Color fundus photograph: 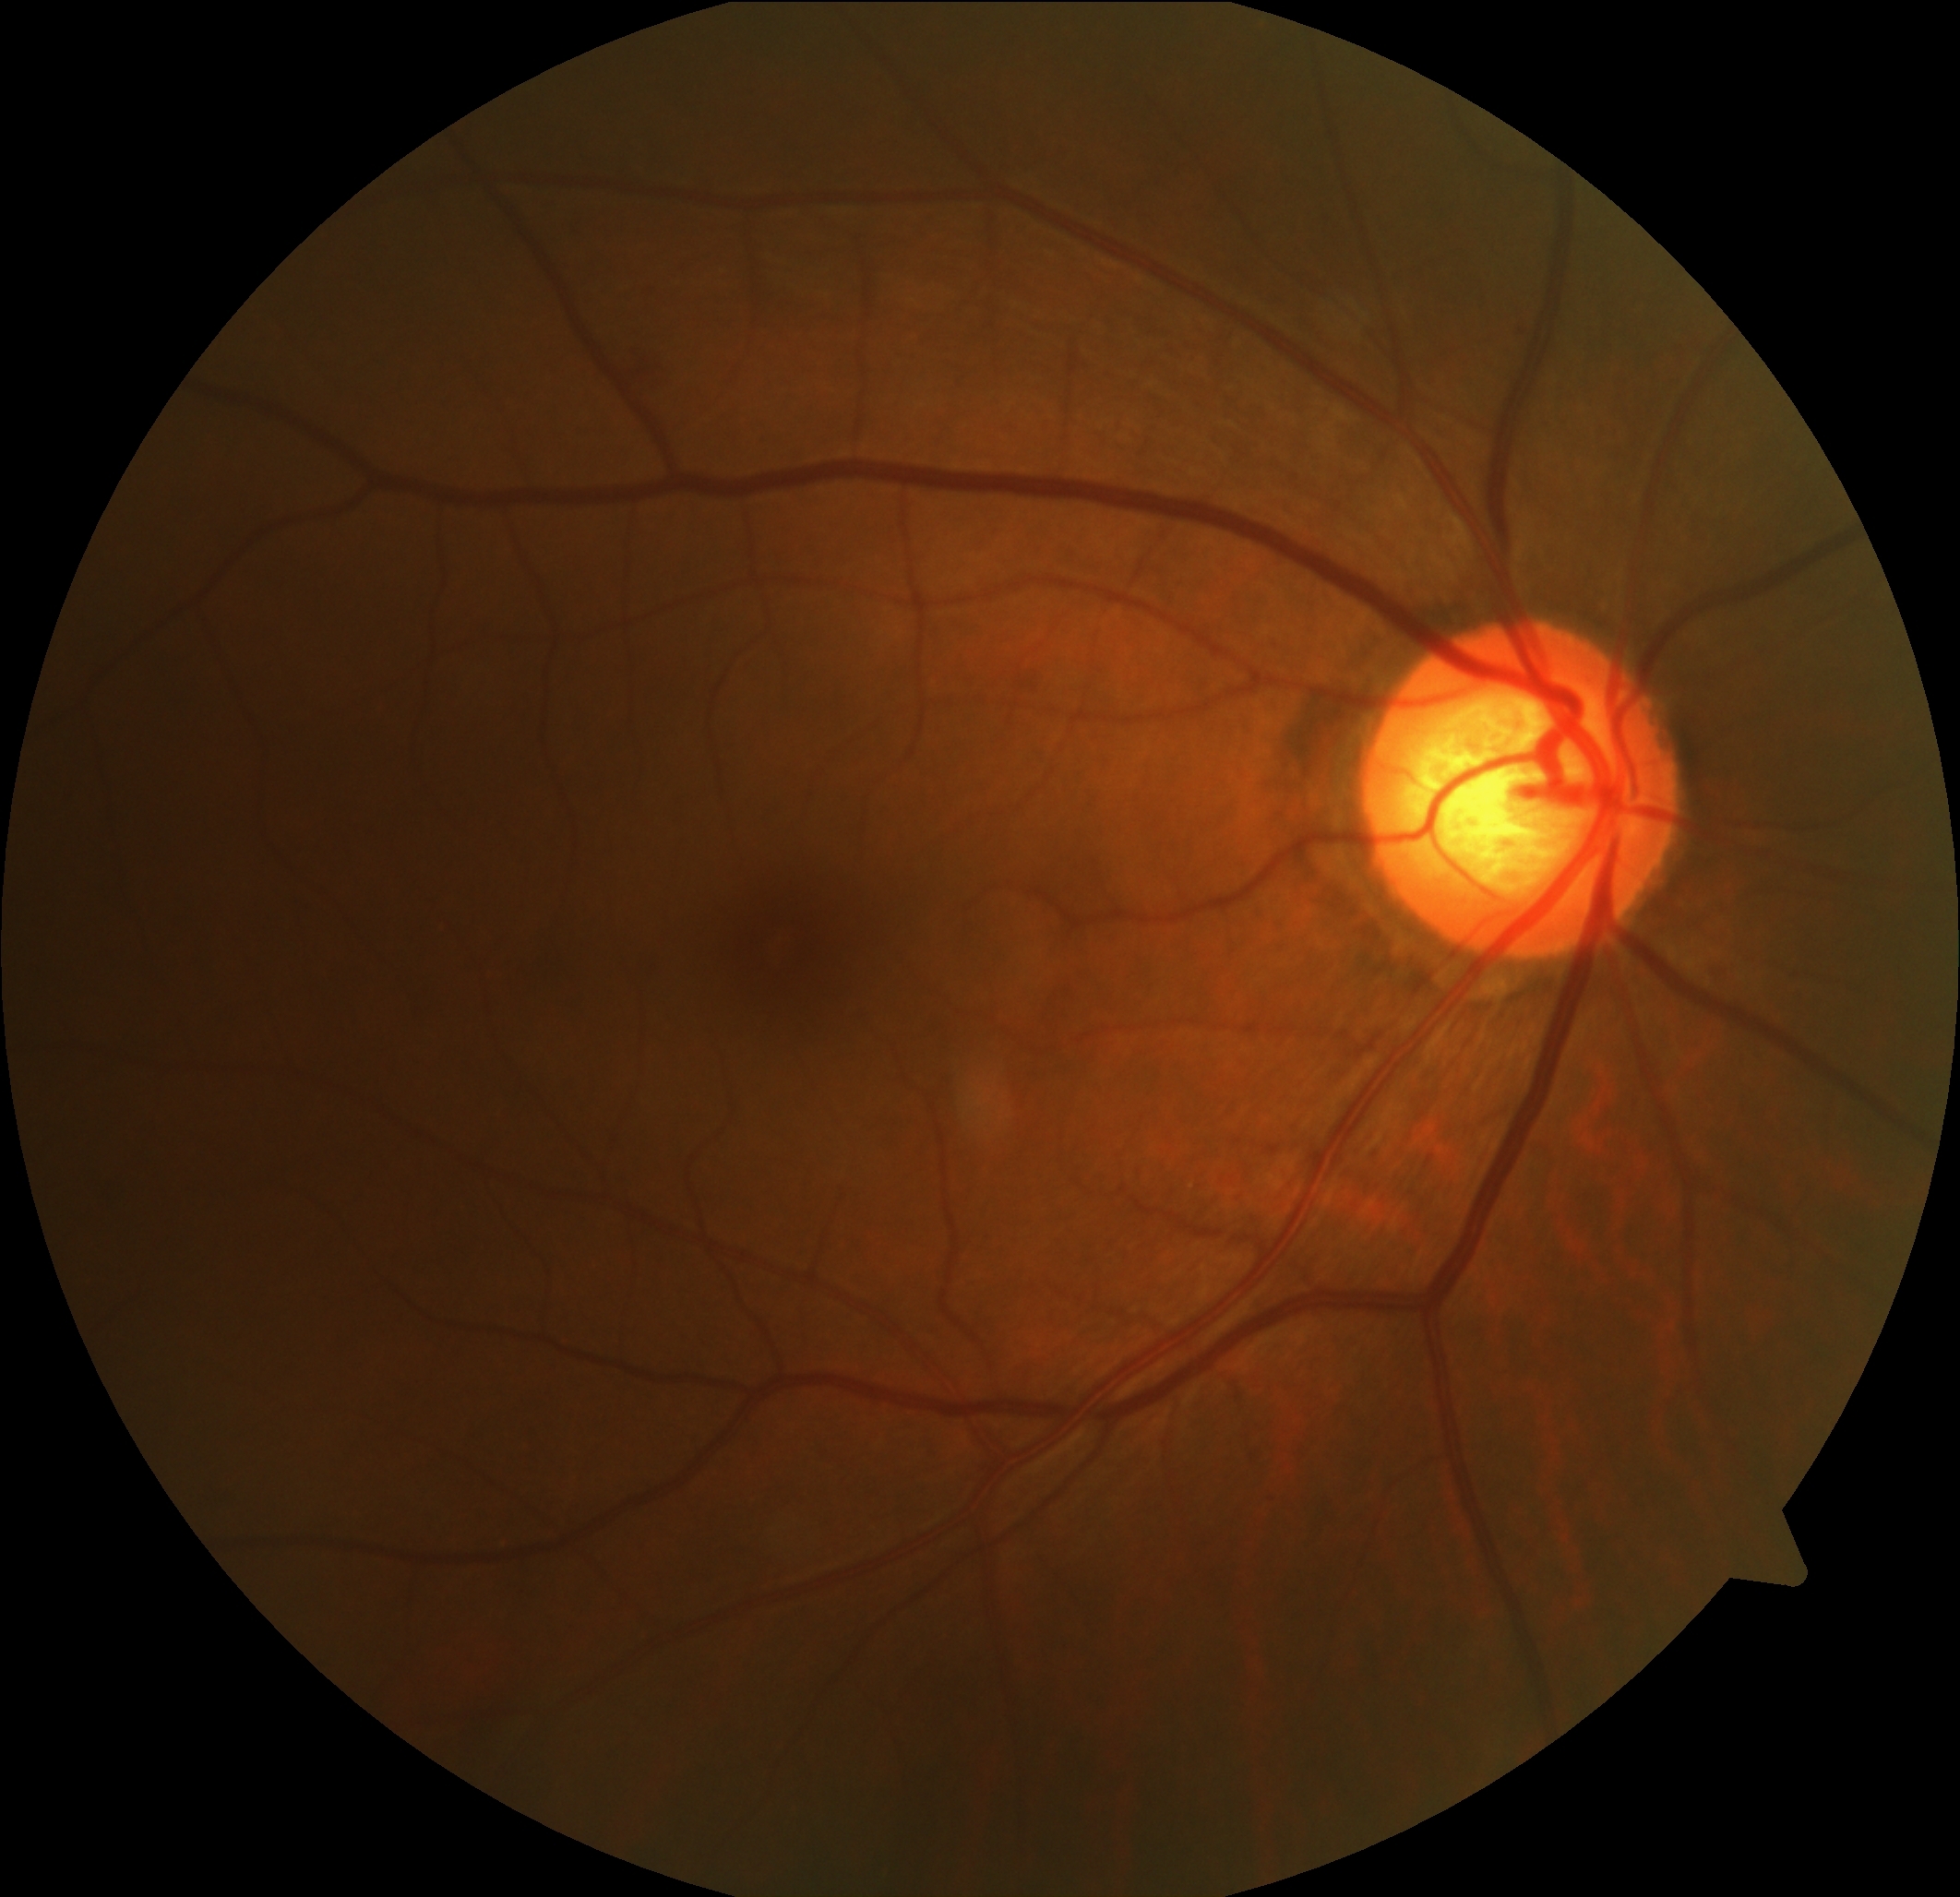

Retinopathy grade is 2/4.